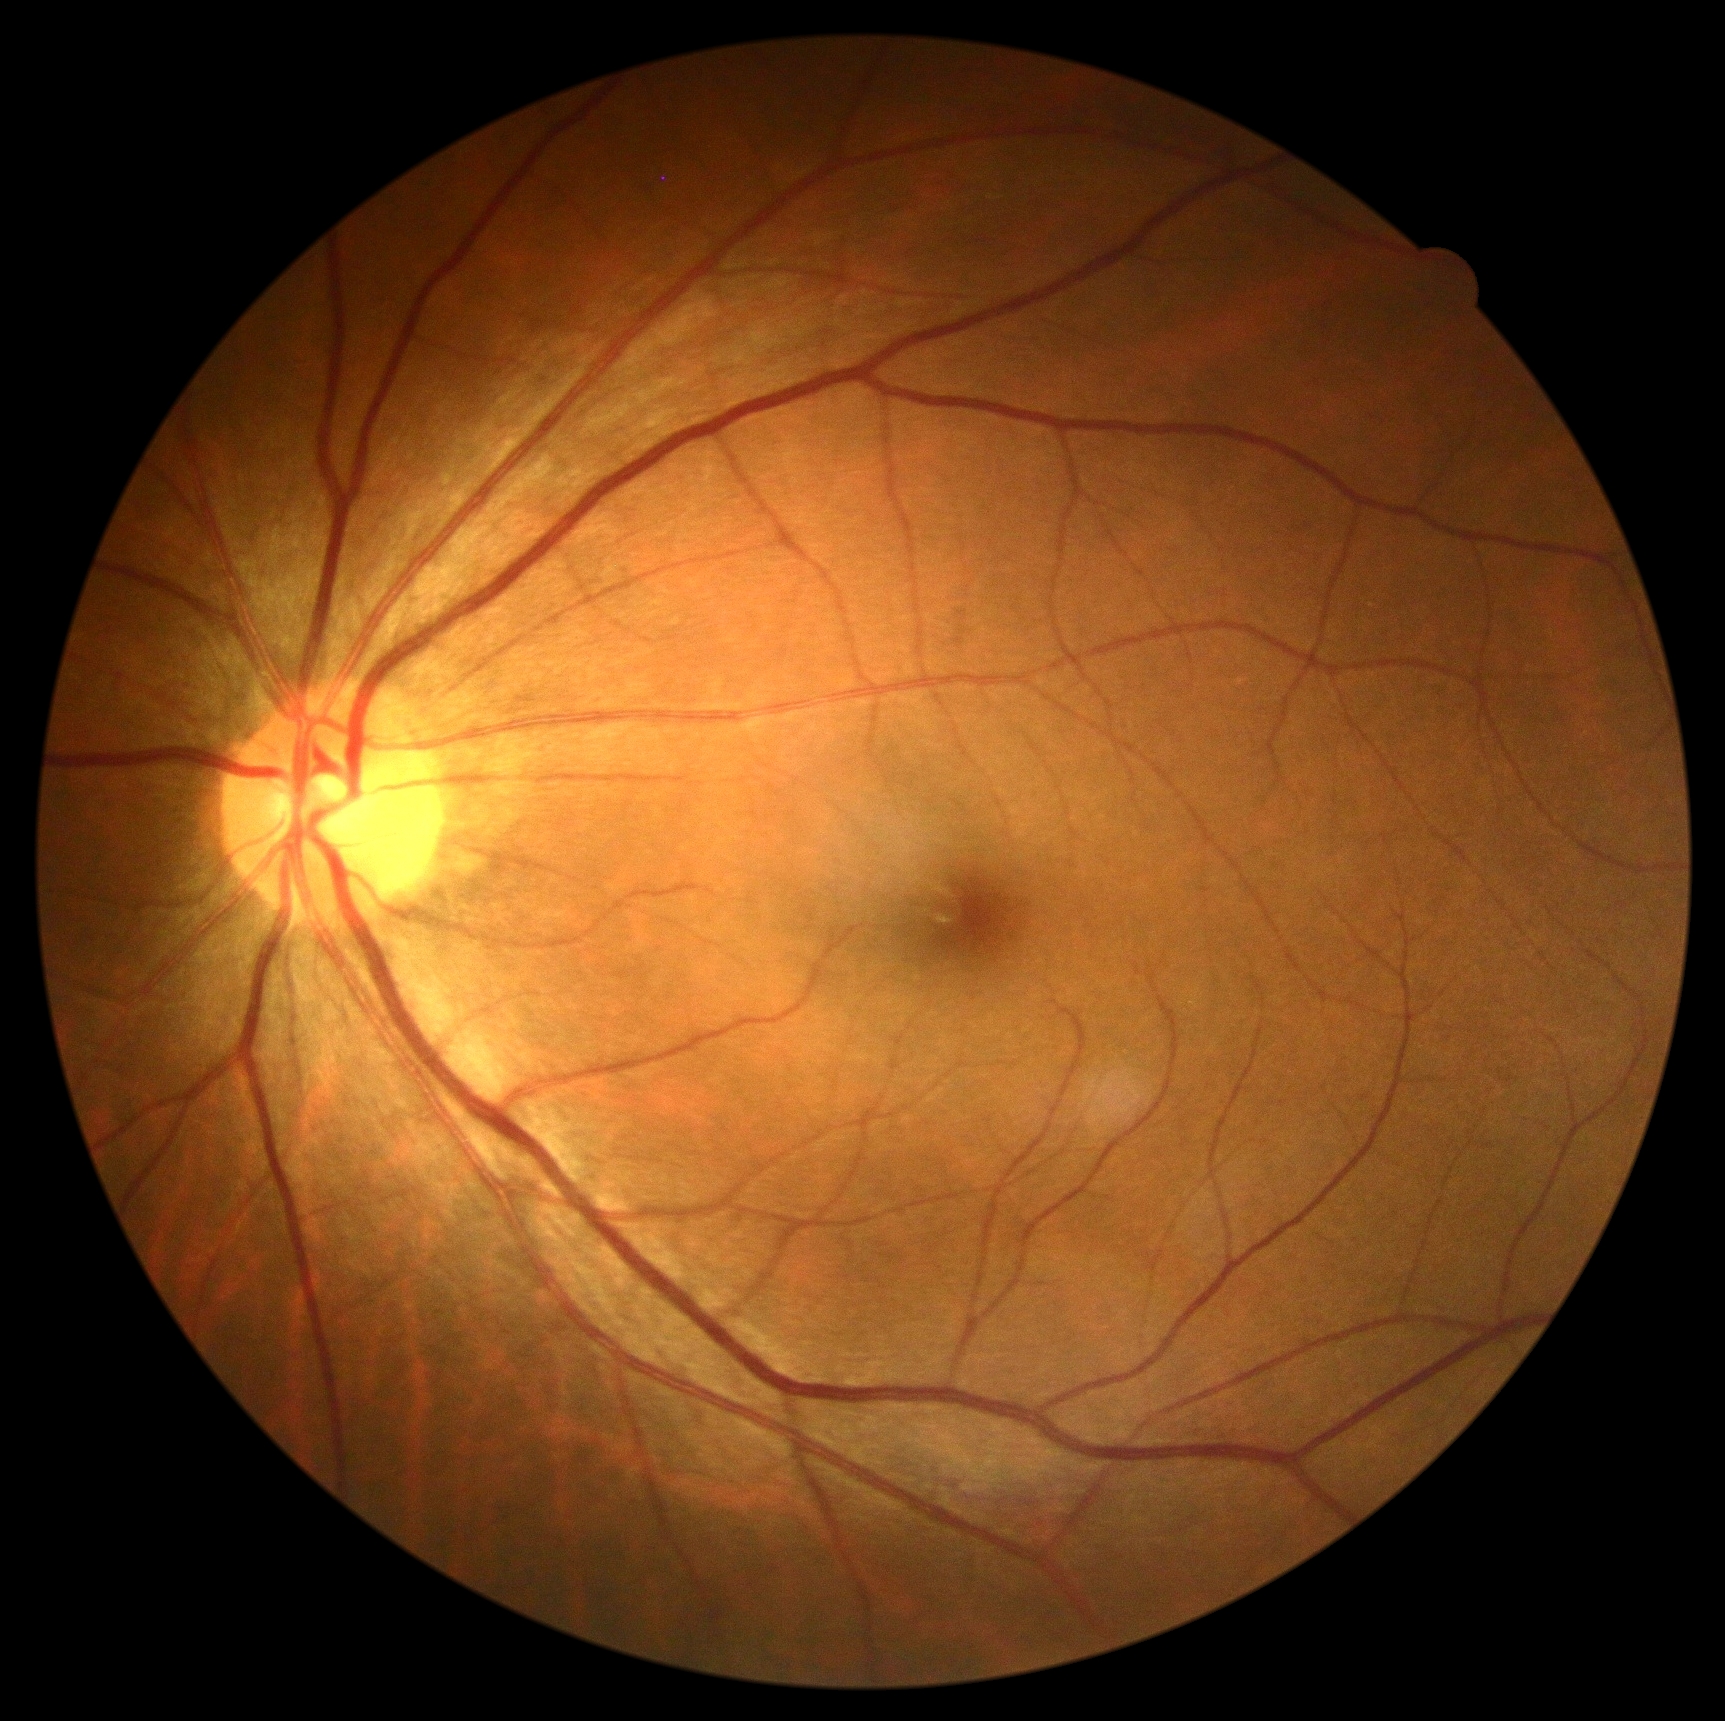 DR impression = no signs of DR, DR grade = 0.